Nonmydriatic — 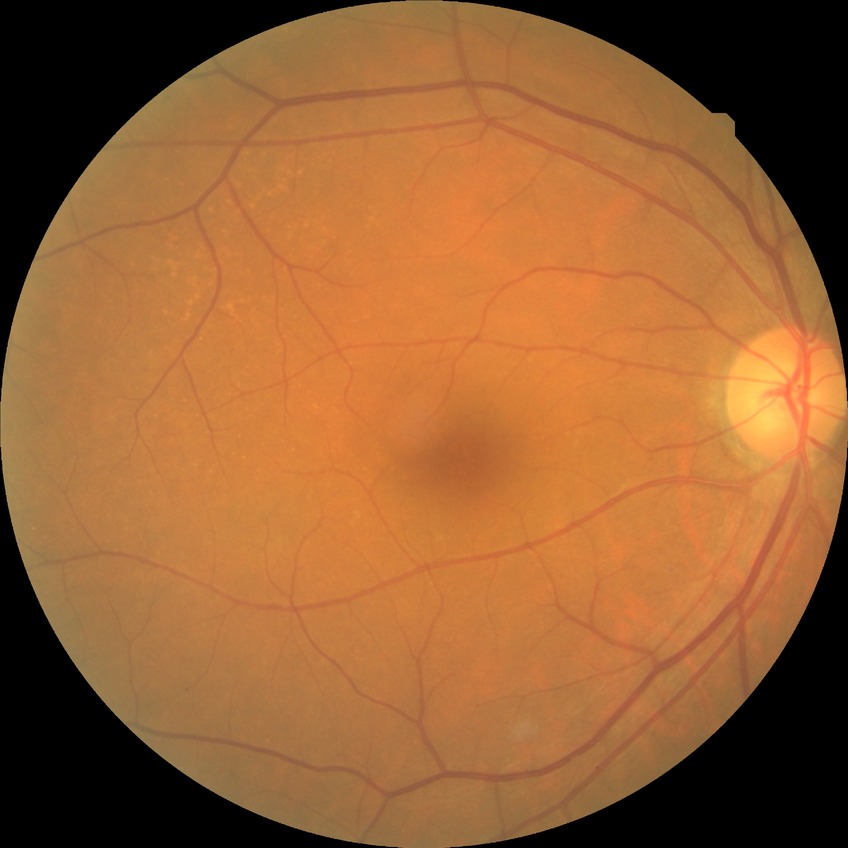 Modified Davis classification is no diabetic retinopathy.